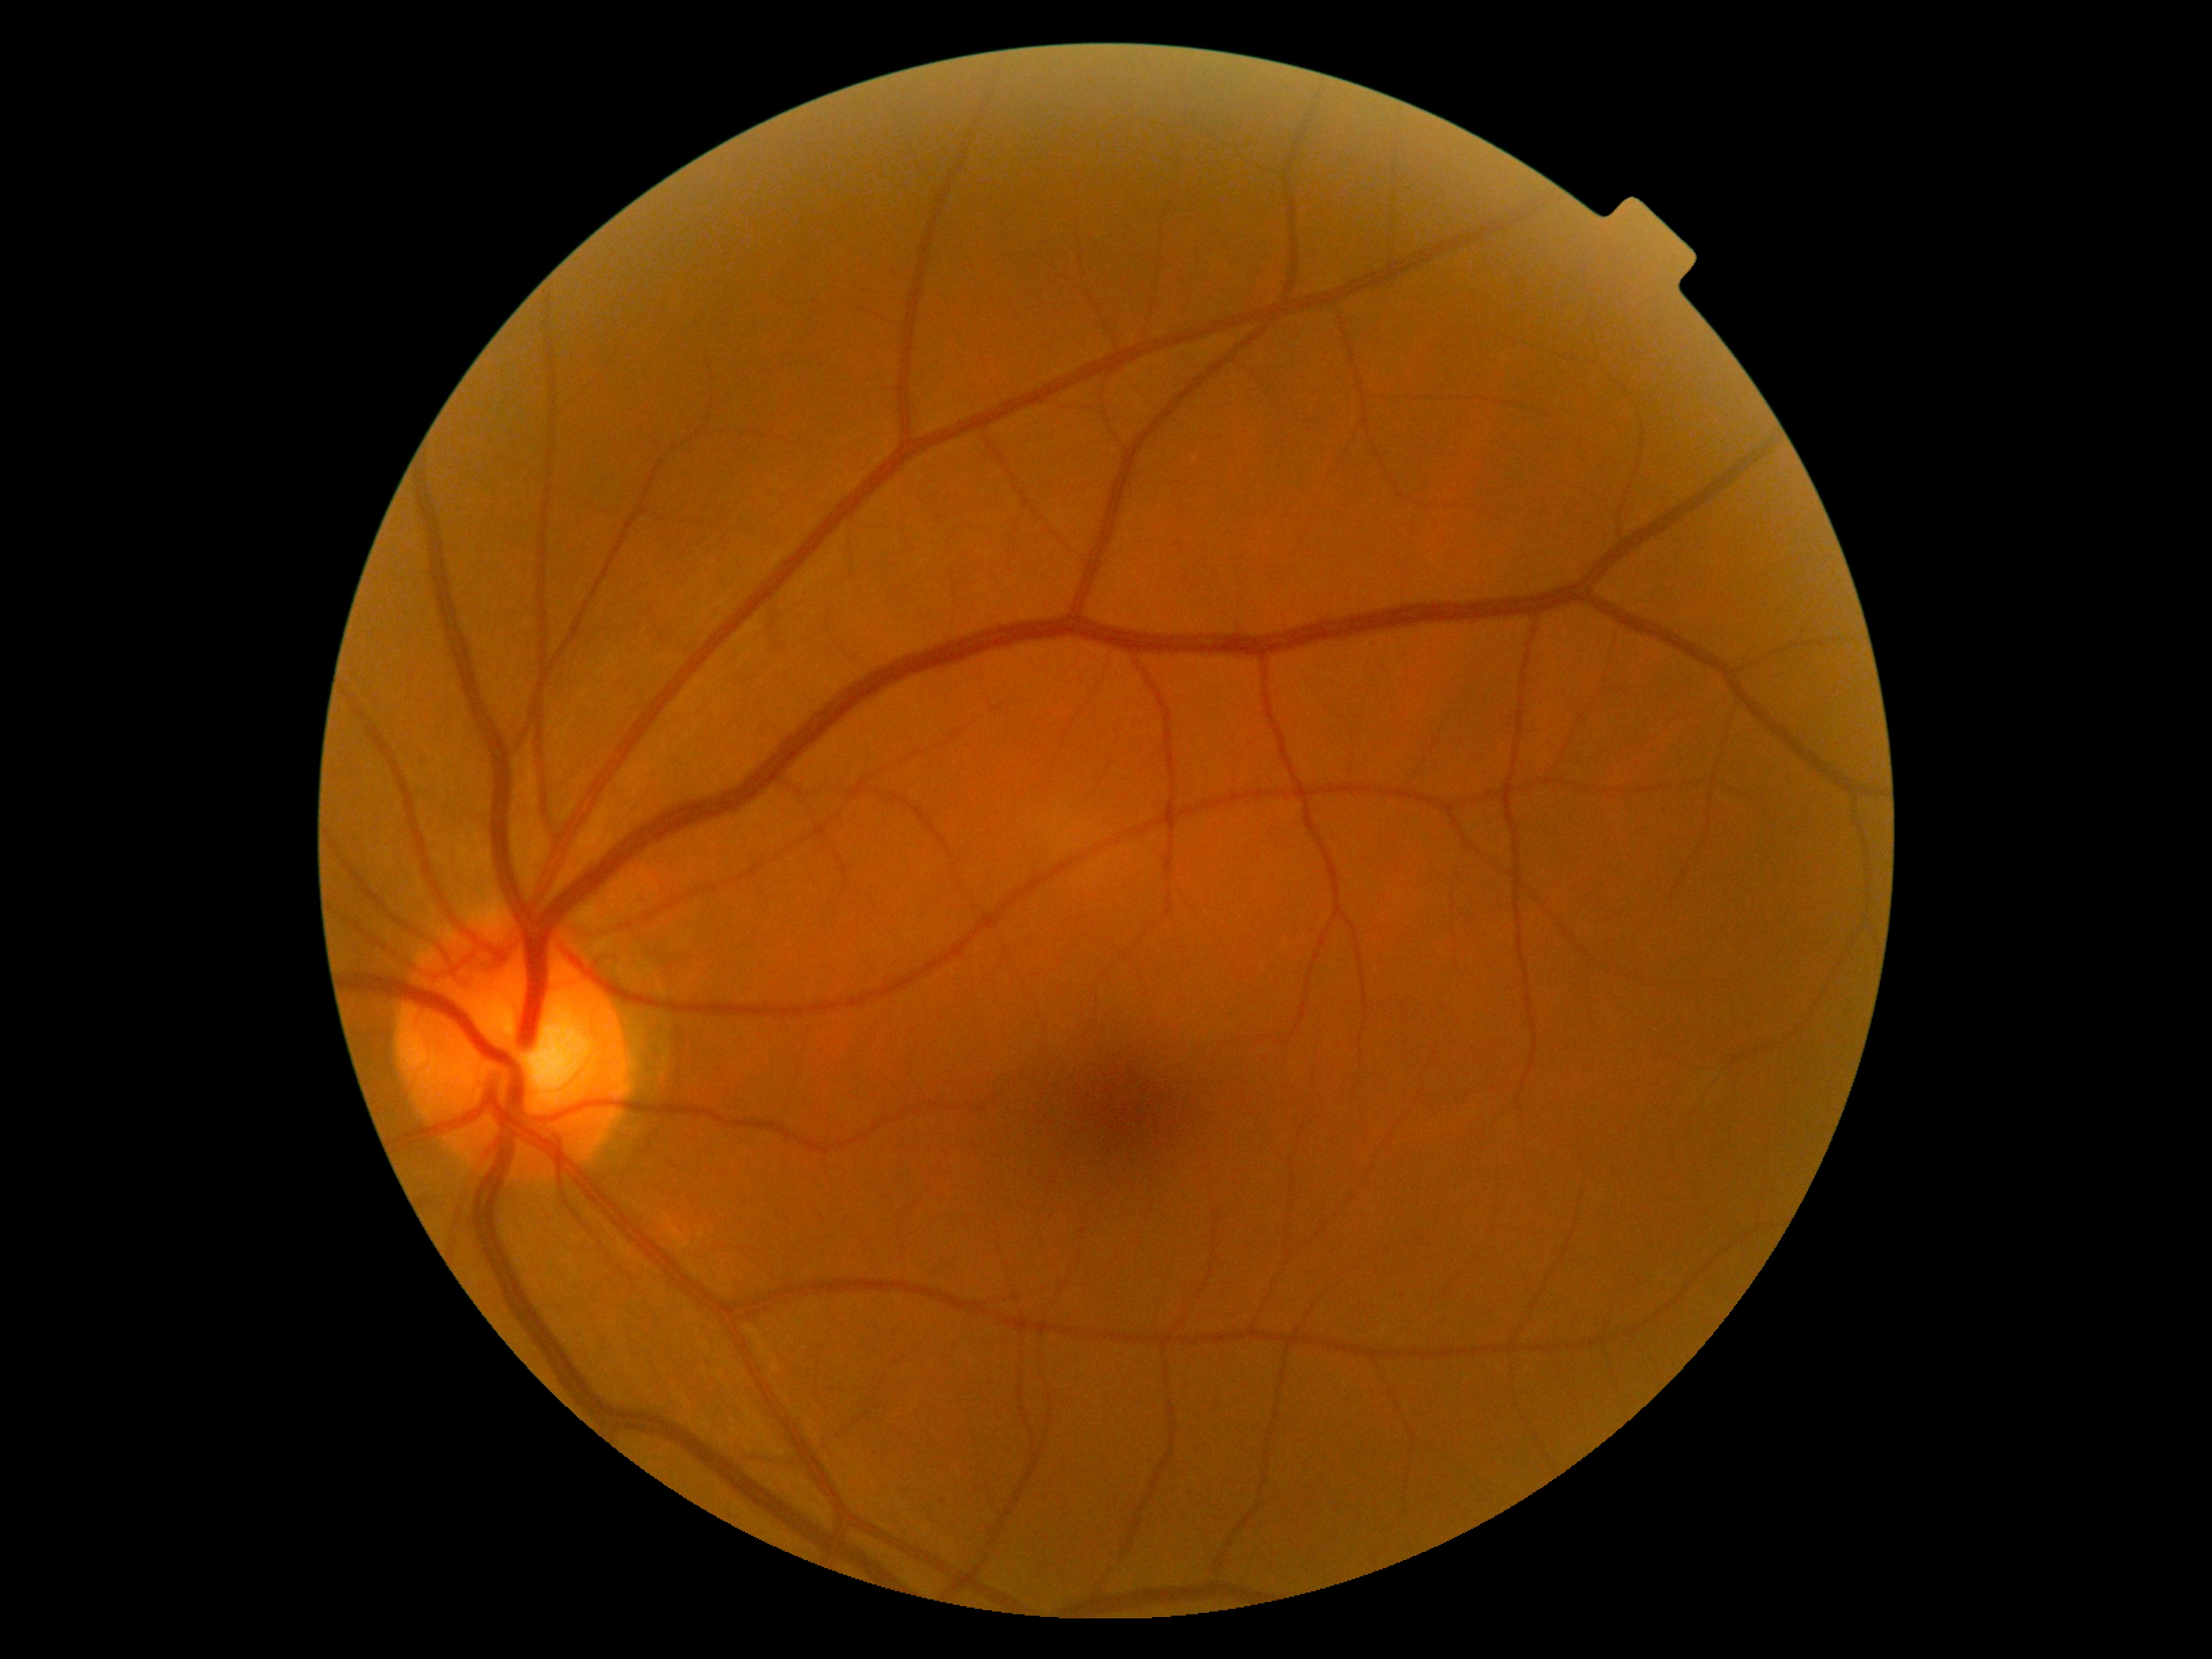
DR grade: 0 (no apparent retinopathy).